848x848px, posterior pole photograph, 45-degree field of view, NIDEK AFC-230: 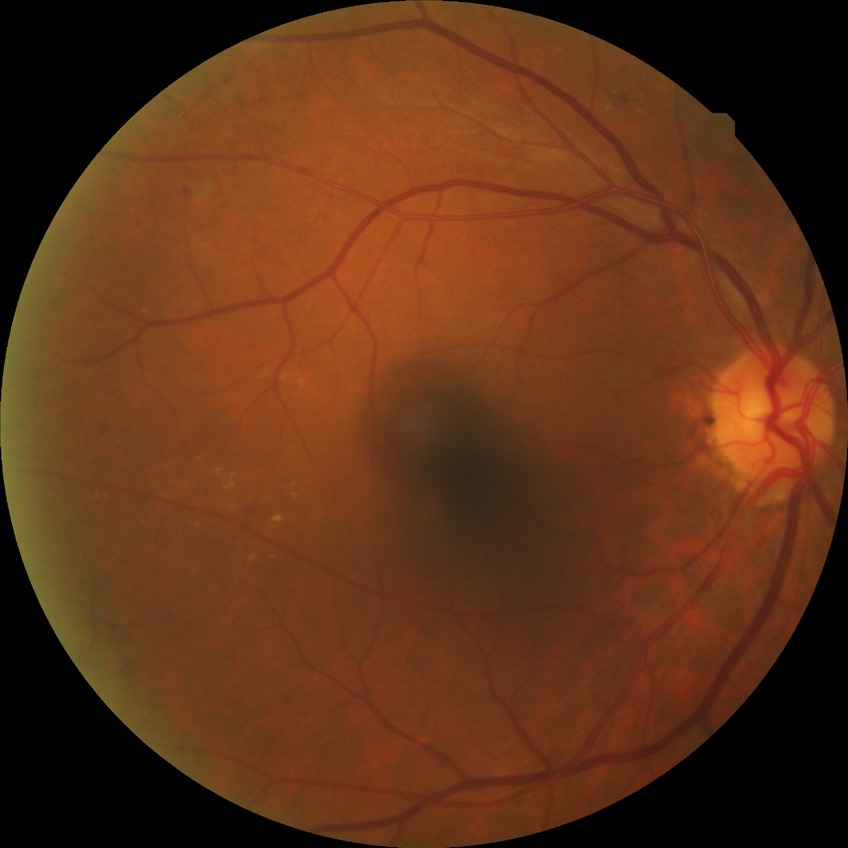

DR severity: SDR.